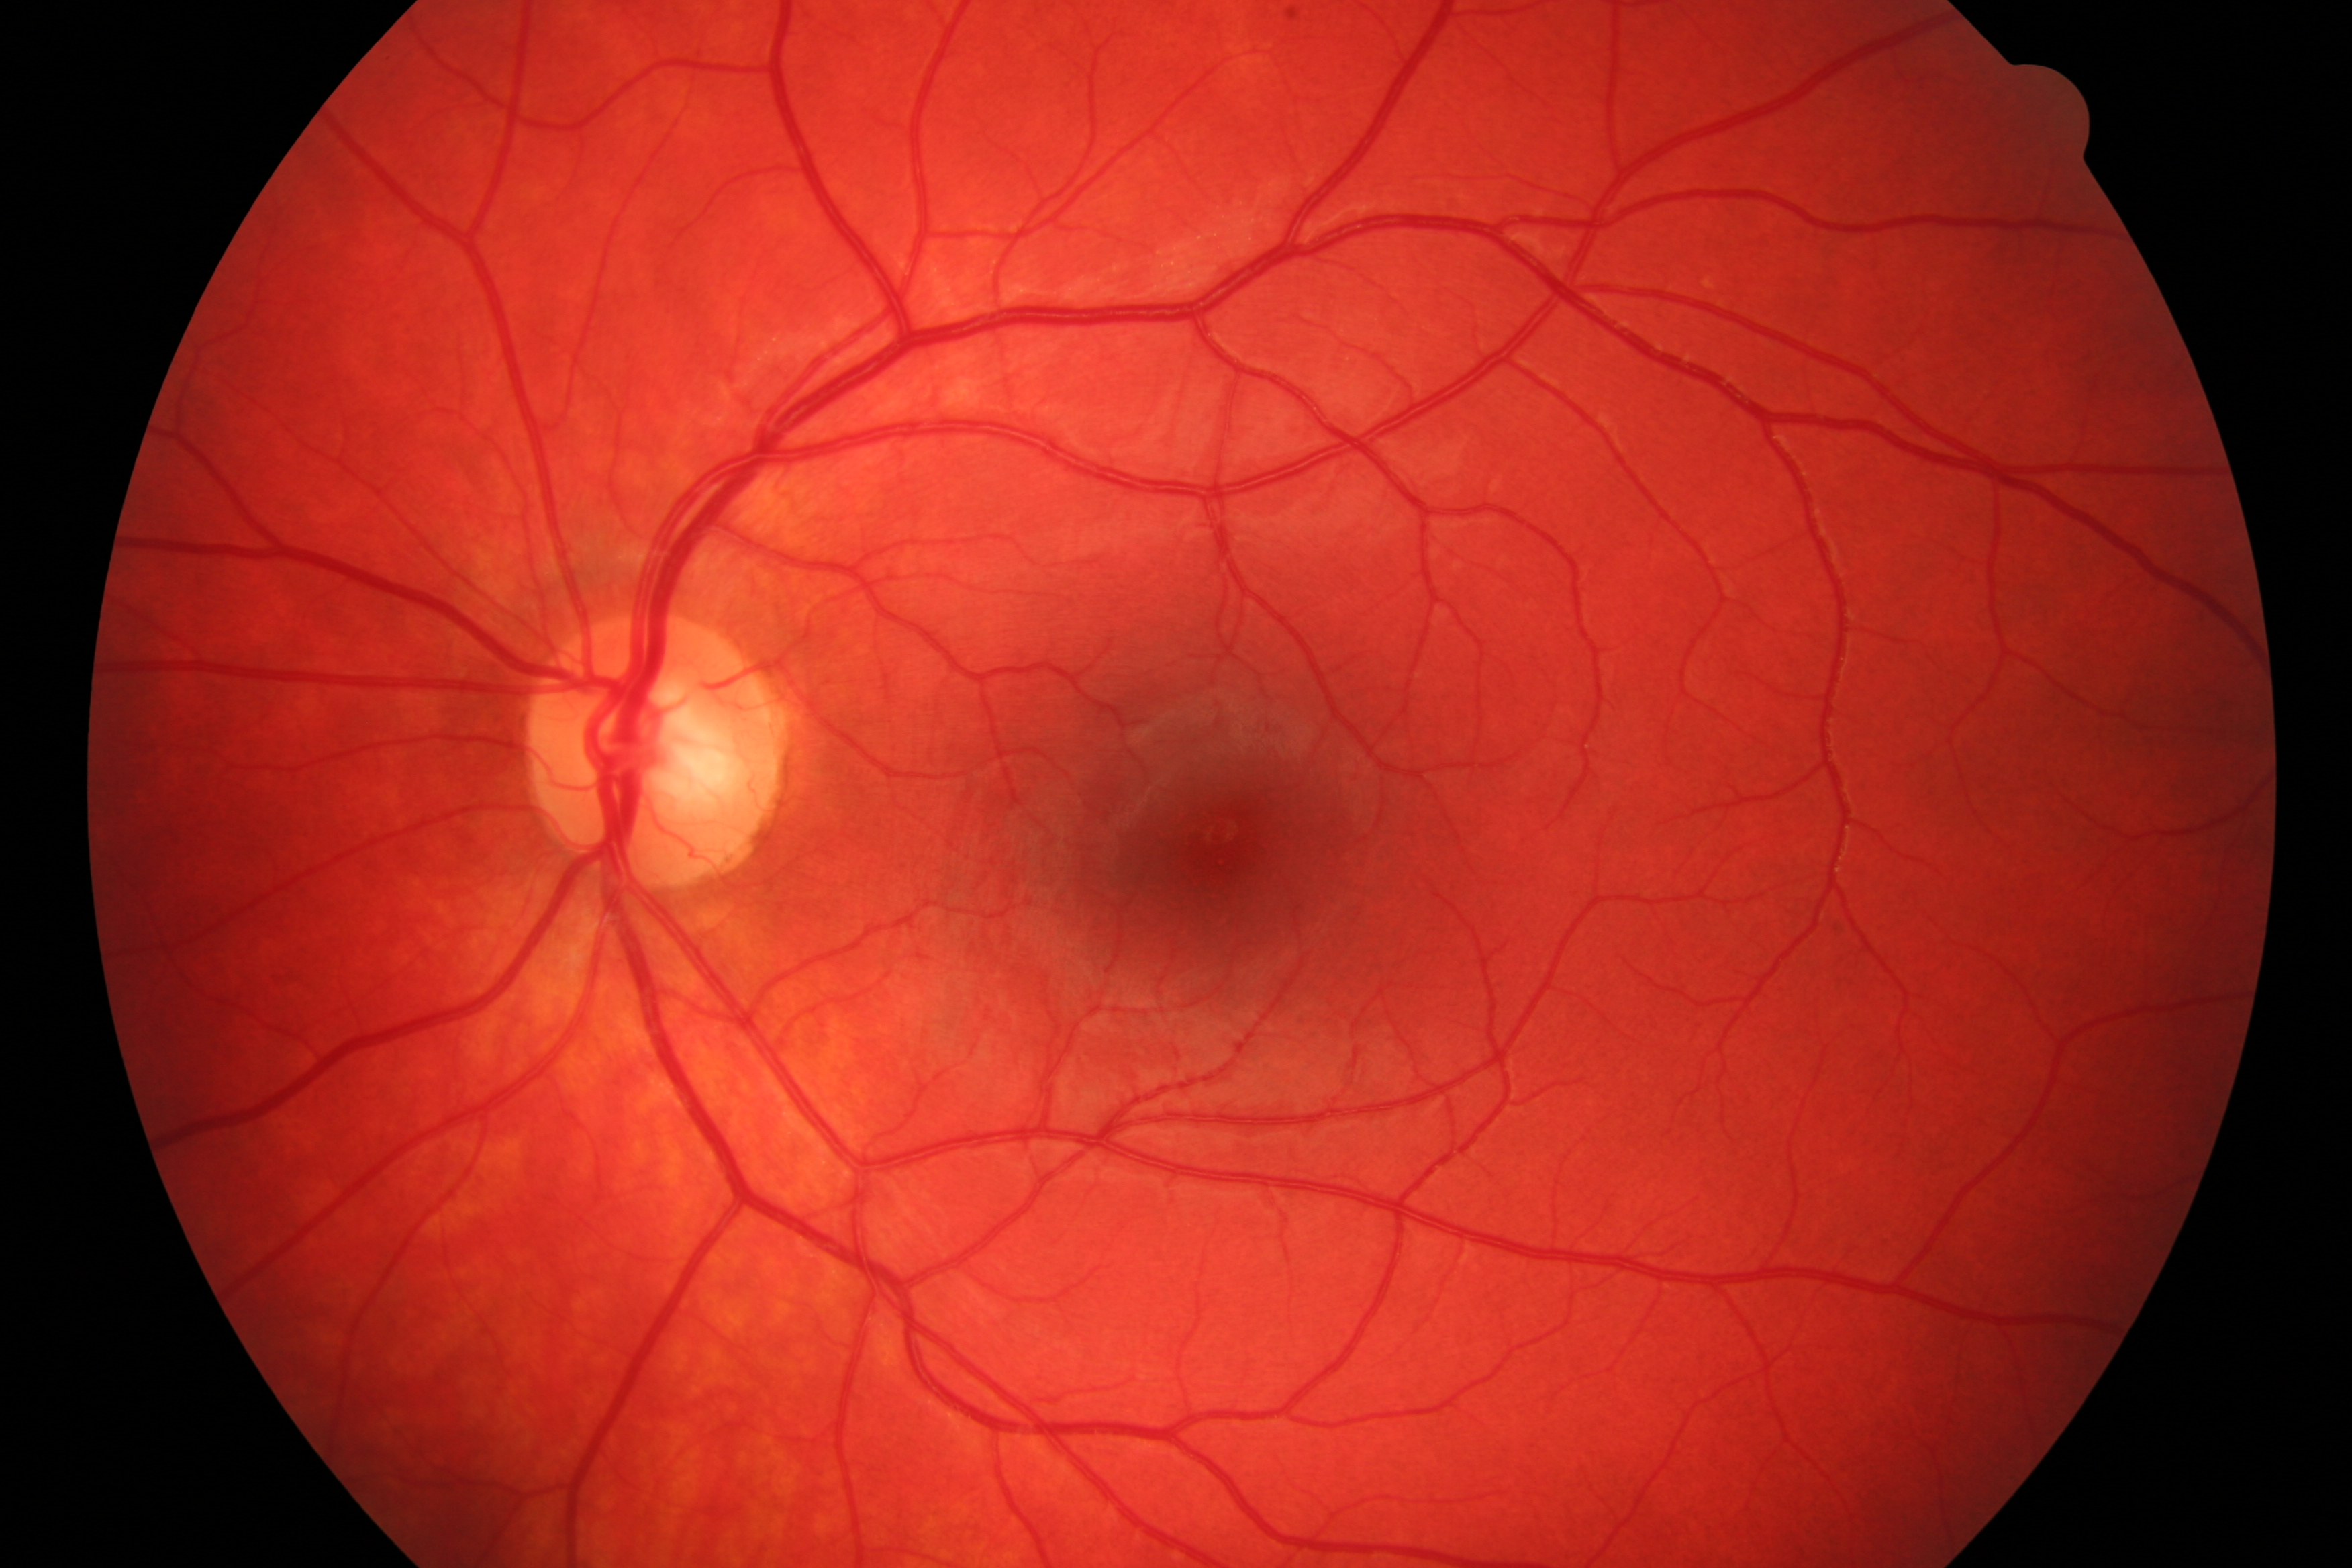 Findings: negative for DR and glaucoma.